2352 x 1568 pixels.
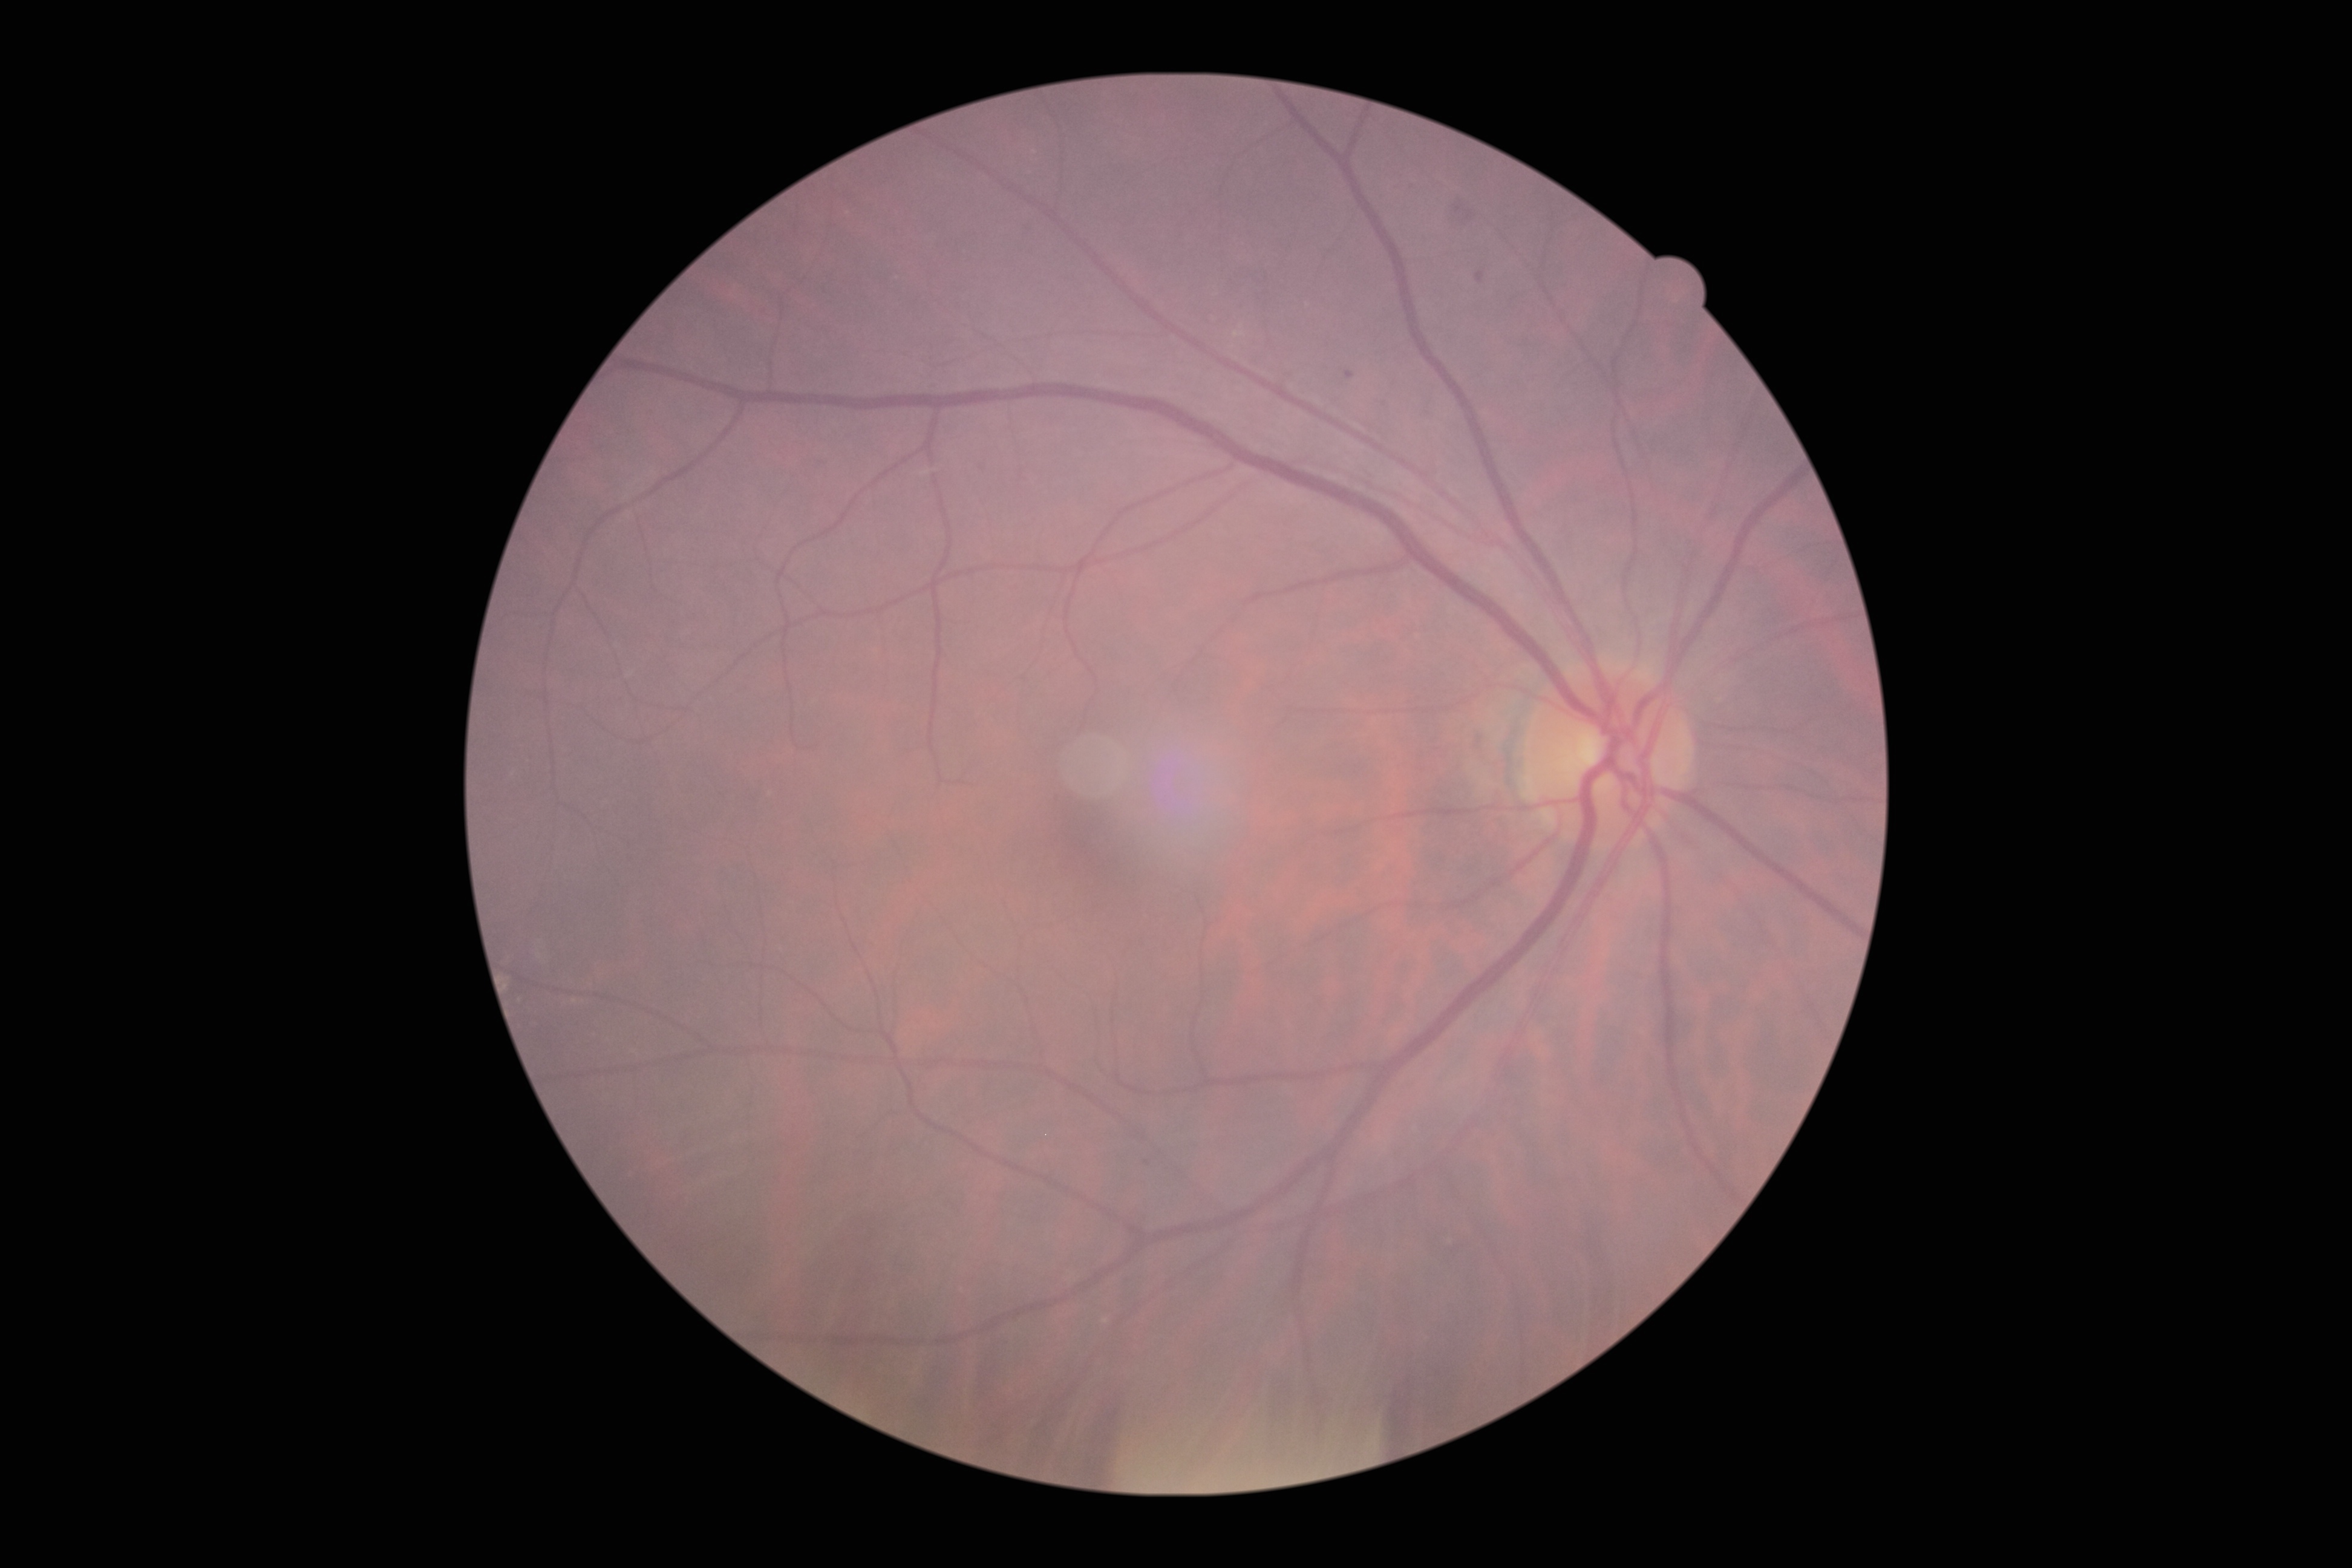

Diabetic retinopathy (DR) is grade 1.